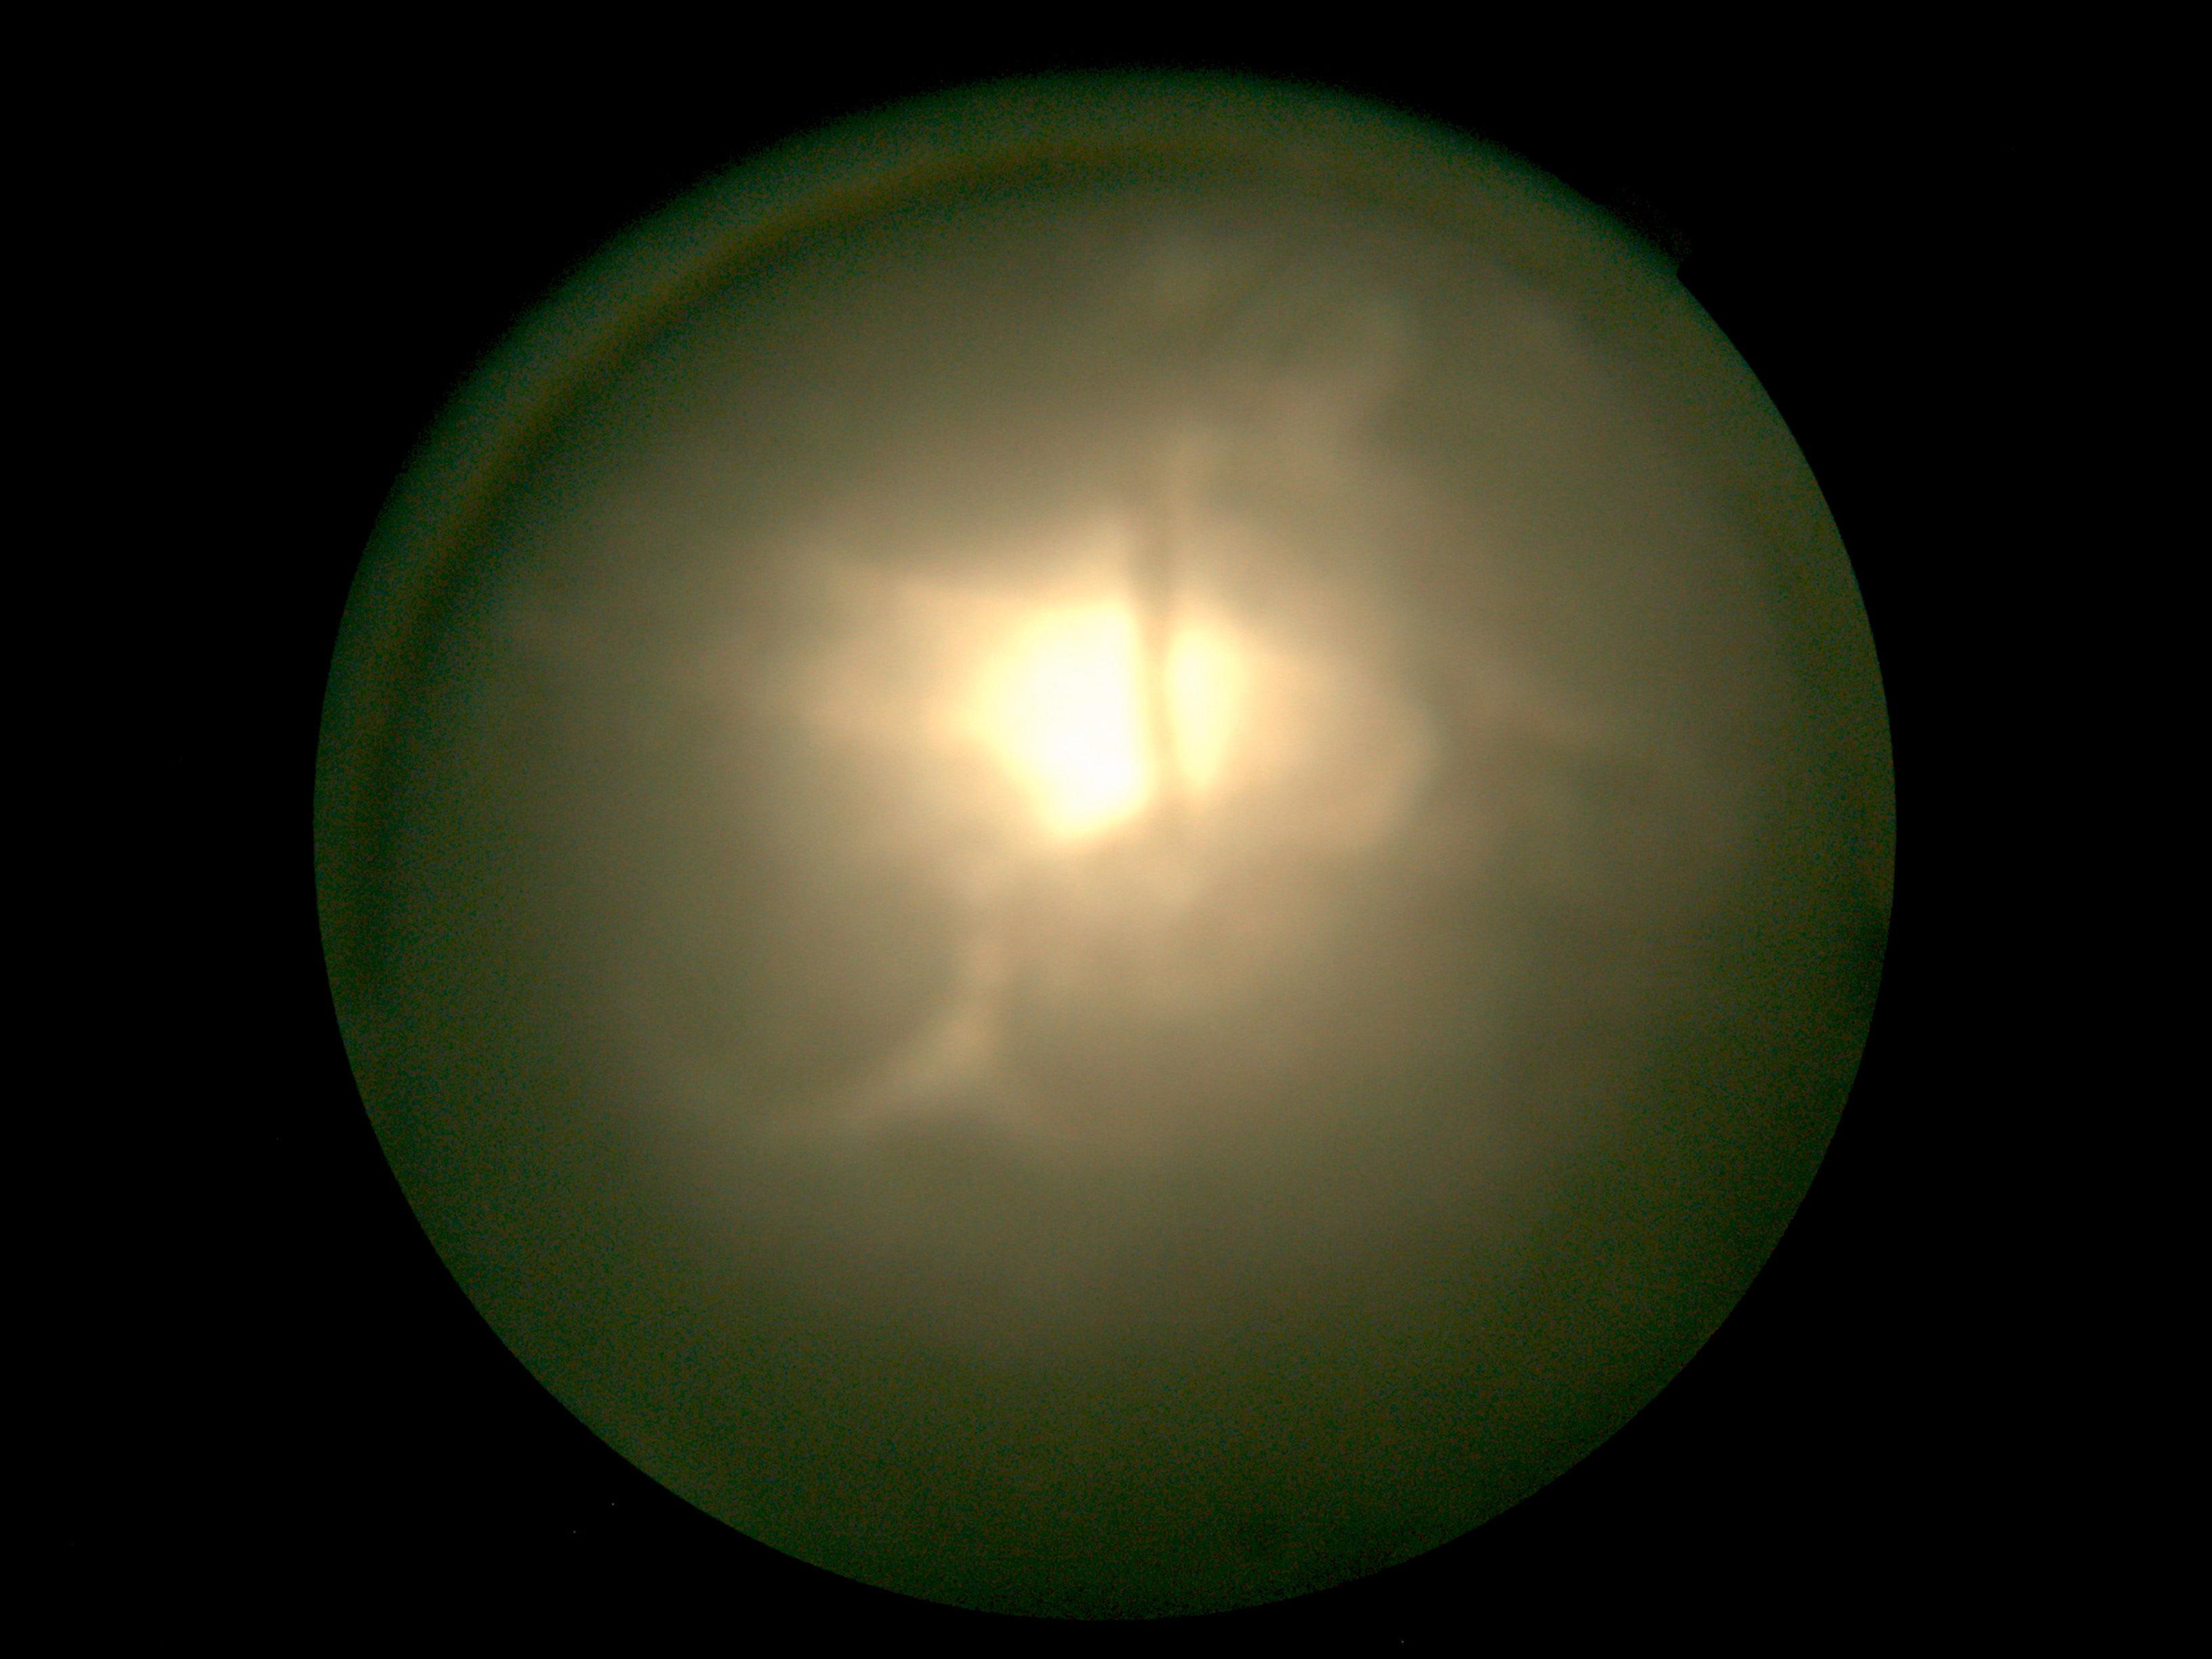   dr_grade: ungradable due to poor image quality